Clarity RetCam 3, 130° FOV. Infant wide-field fundus photograph. 640 x 480 pixels:
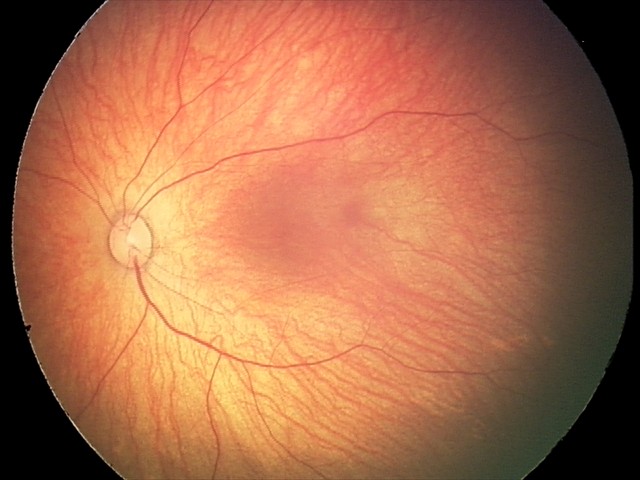
From an examination with diagnosis of retinal hemorrhages.